RetCam wide-field infant fundus image.
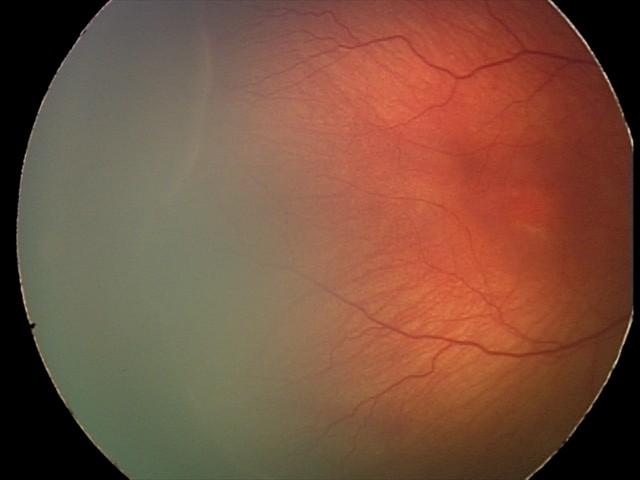 Plus disease: absent
screening diagnosis: retinopathy of prematurity (ROP) stage 2 — ridge with height and width at the demarcation line